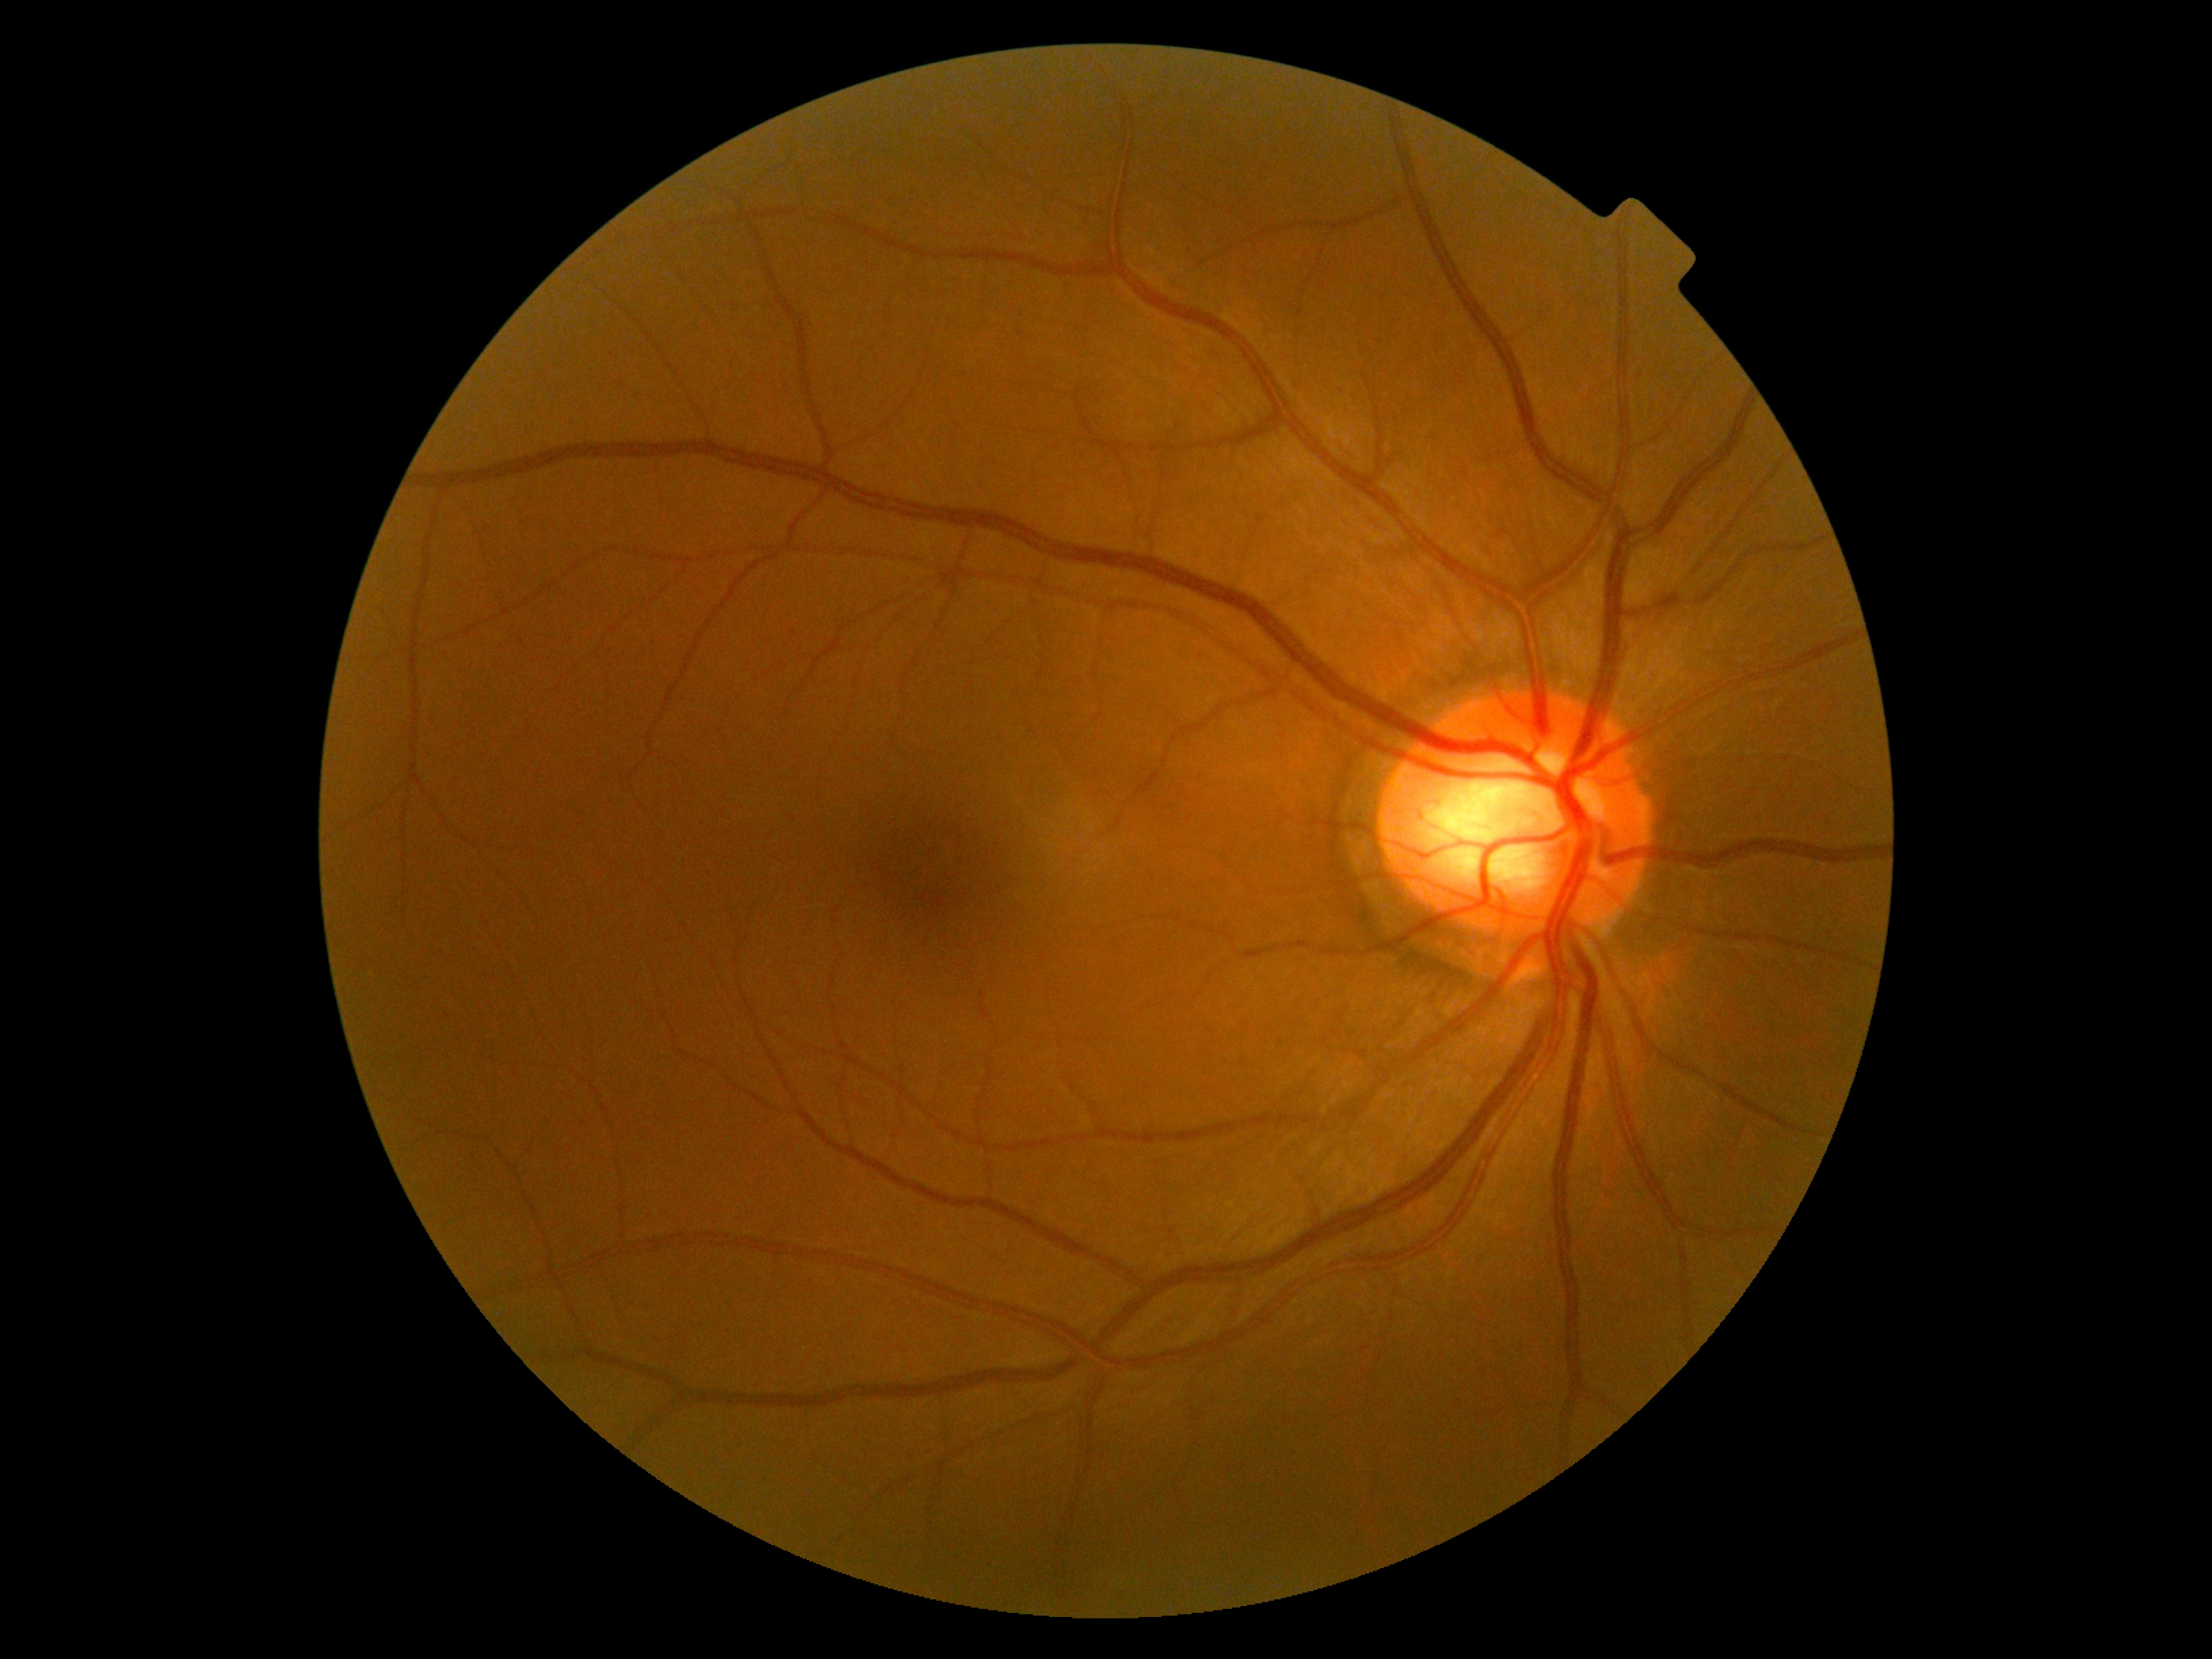 Diabetic retinopathy: grade 0 (no apparent retinopathy).